RetCam wide-field infant fundus image; 640 by 480 pixels; captured with the Clarity RetCam 3 (130° field of view).
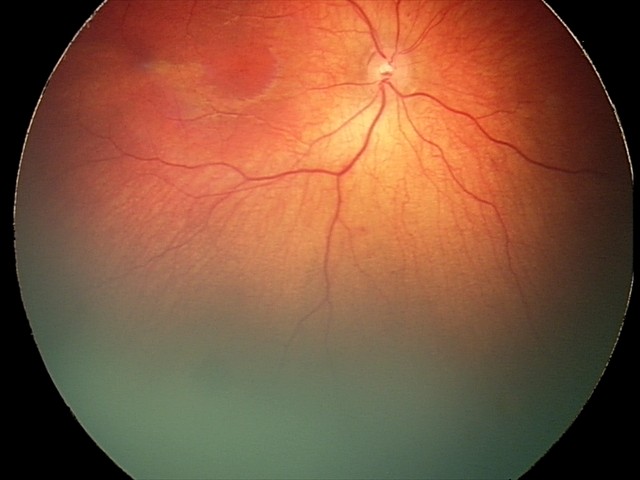 Screening diagnosis: retinal hemorrhages